Wide-field fundus image from infant ROP screening; acquired on the Phoenix ICON — 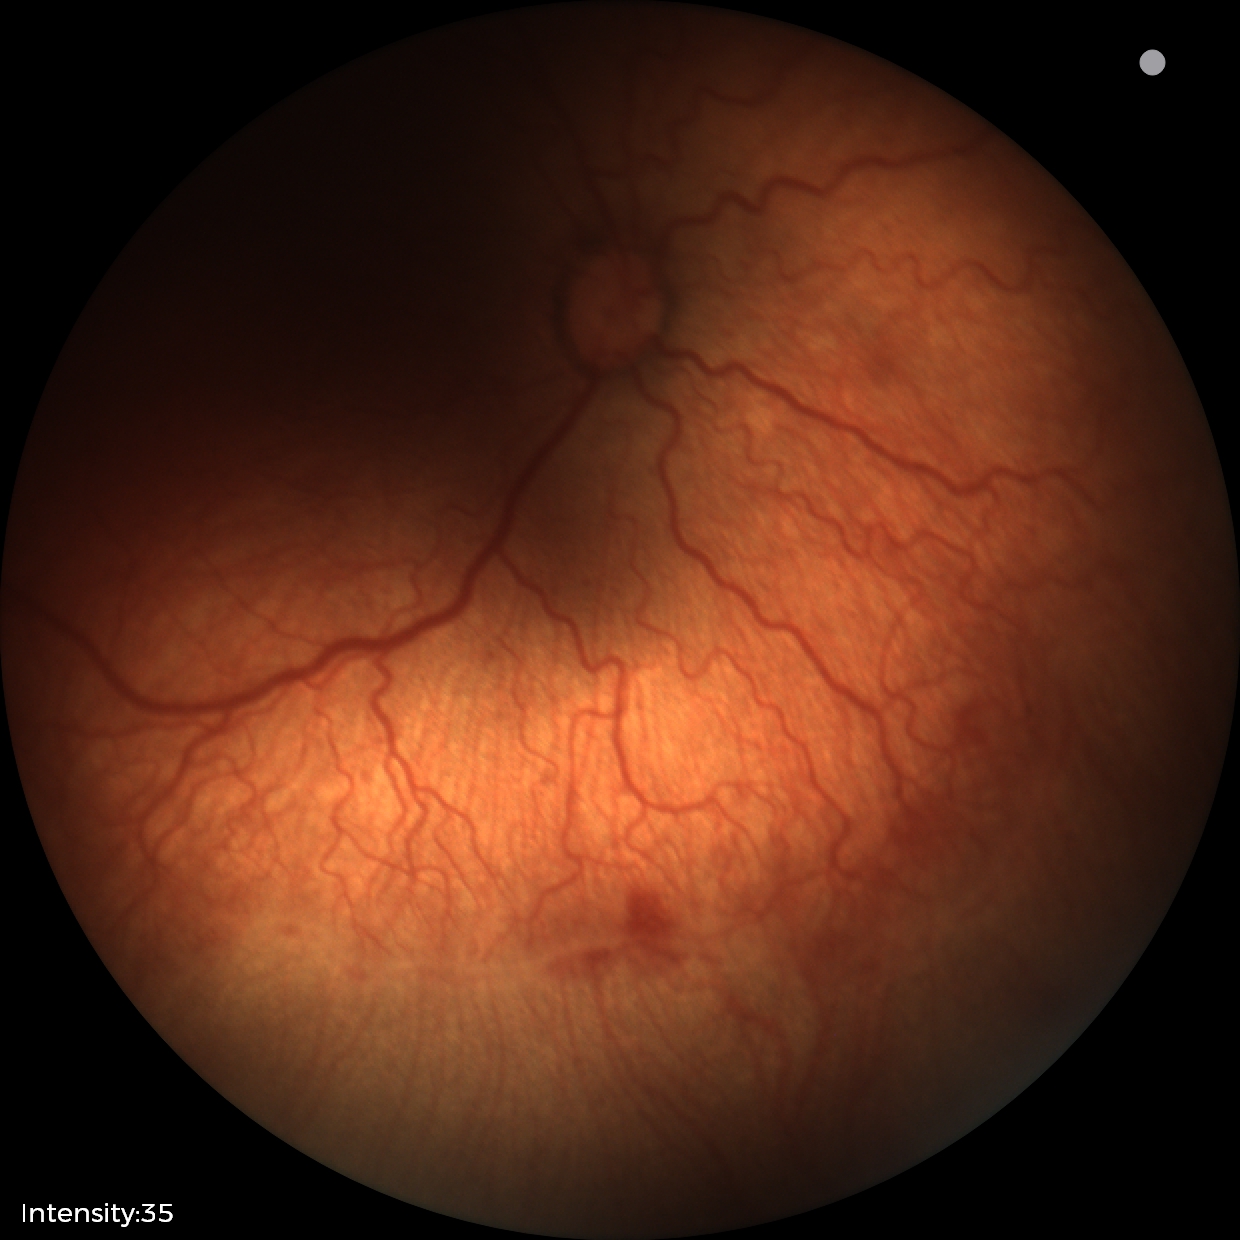
Diagnosis from this screening exam: retinopathy of prematurity stage 2. With plus disease.